NIDEK AFC-230 fundus camera
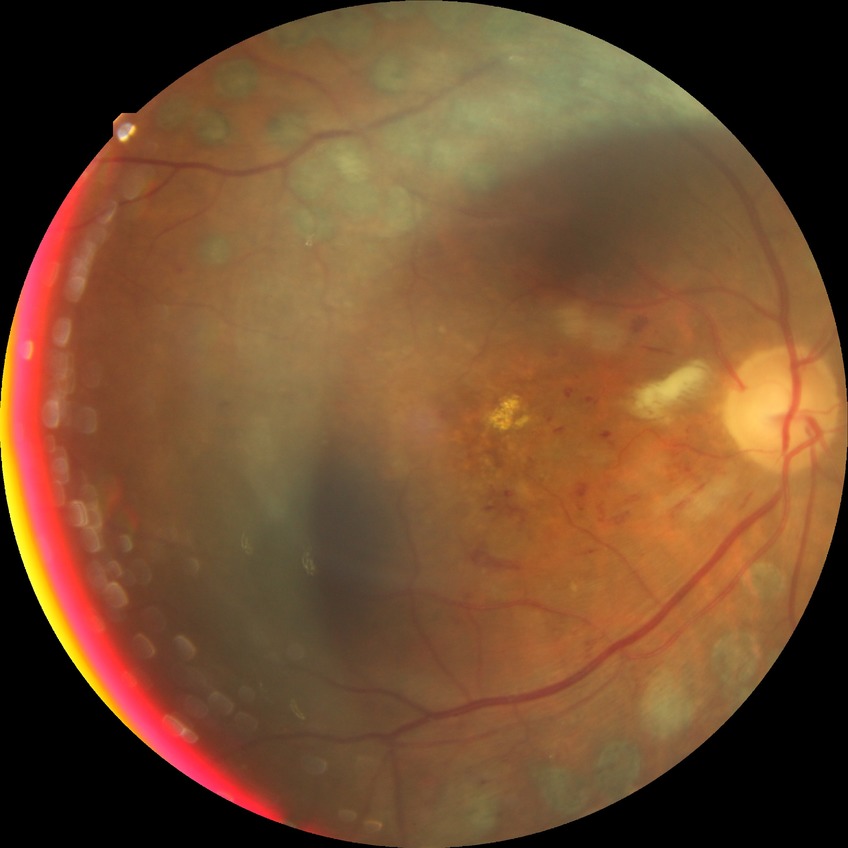

Diabetic retinopathy (DR): pre-proliferative diabetic retinopathy (PPDR).